Color fundus image. 45° FOV. 2212x1659 — 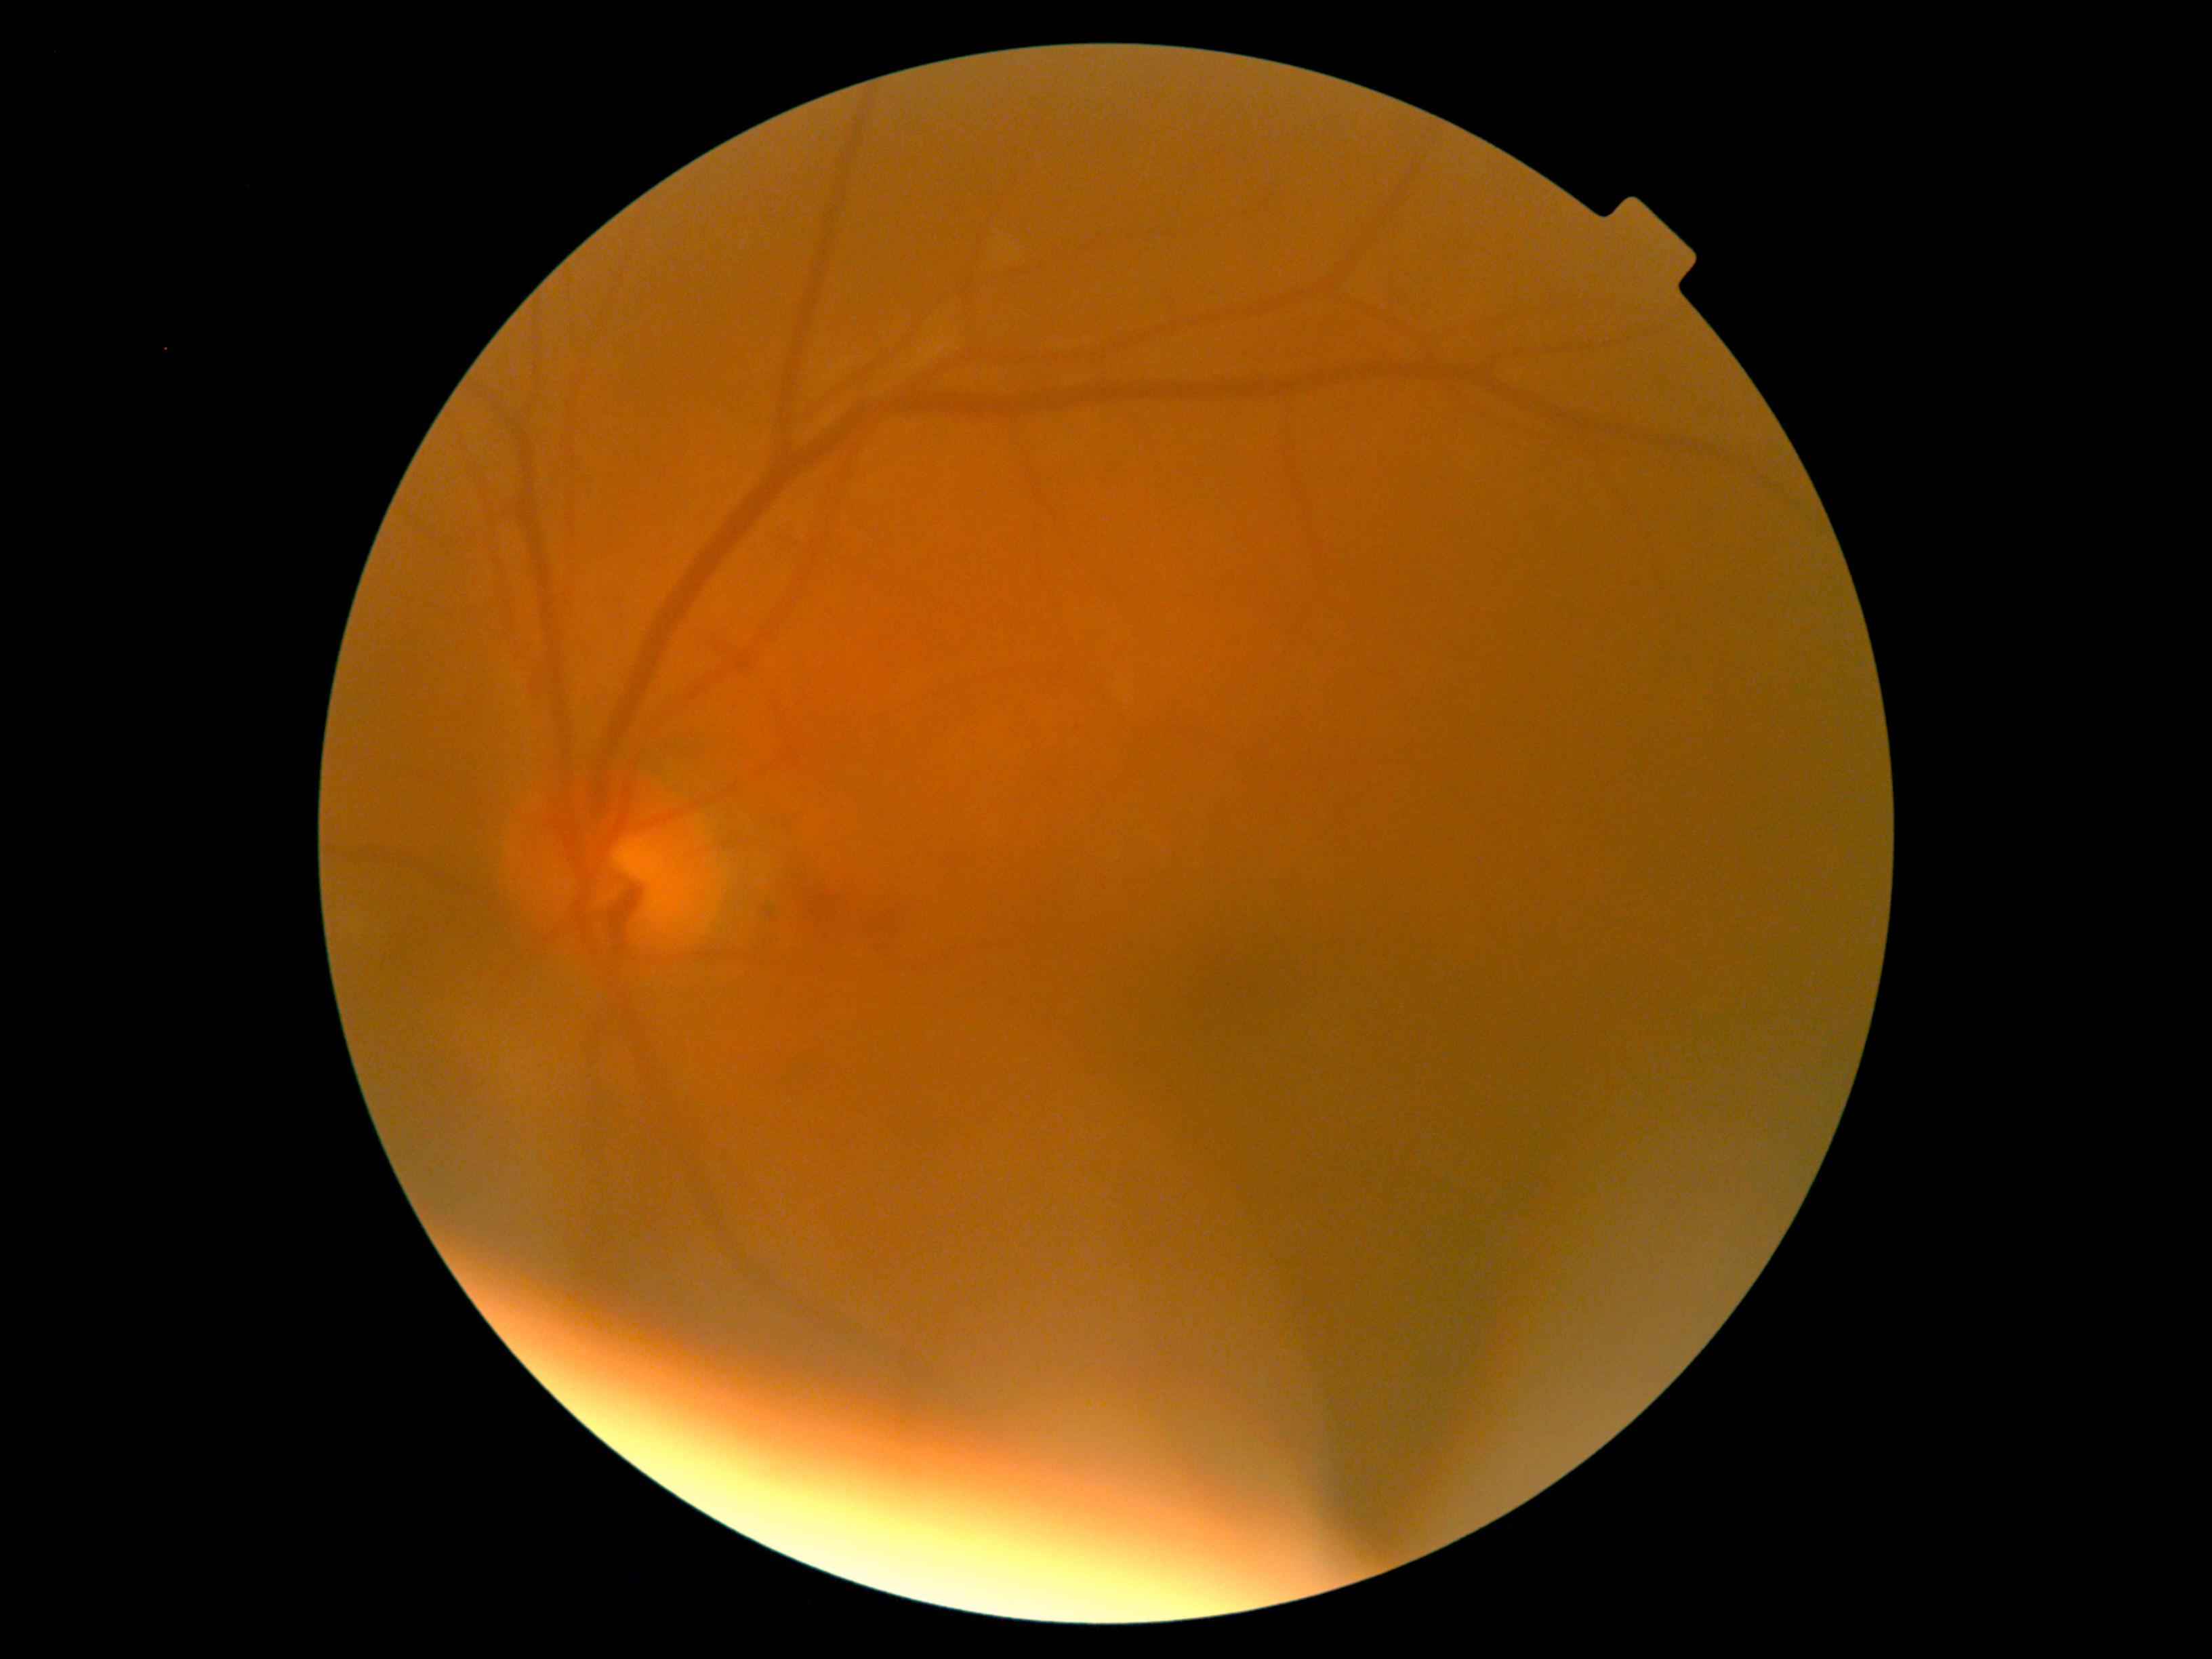 diabetic retinopathy (DR) = 2/4 — more than just microaneurysms but less than severe NPDR.